Wide-field fundus photograph from neonatal ROP screening:
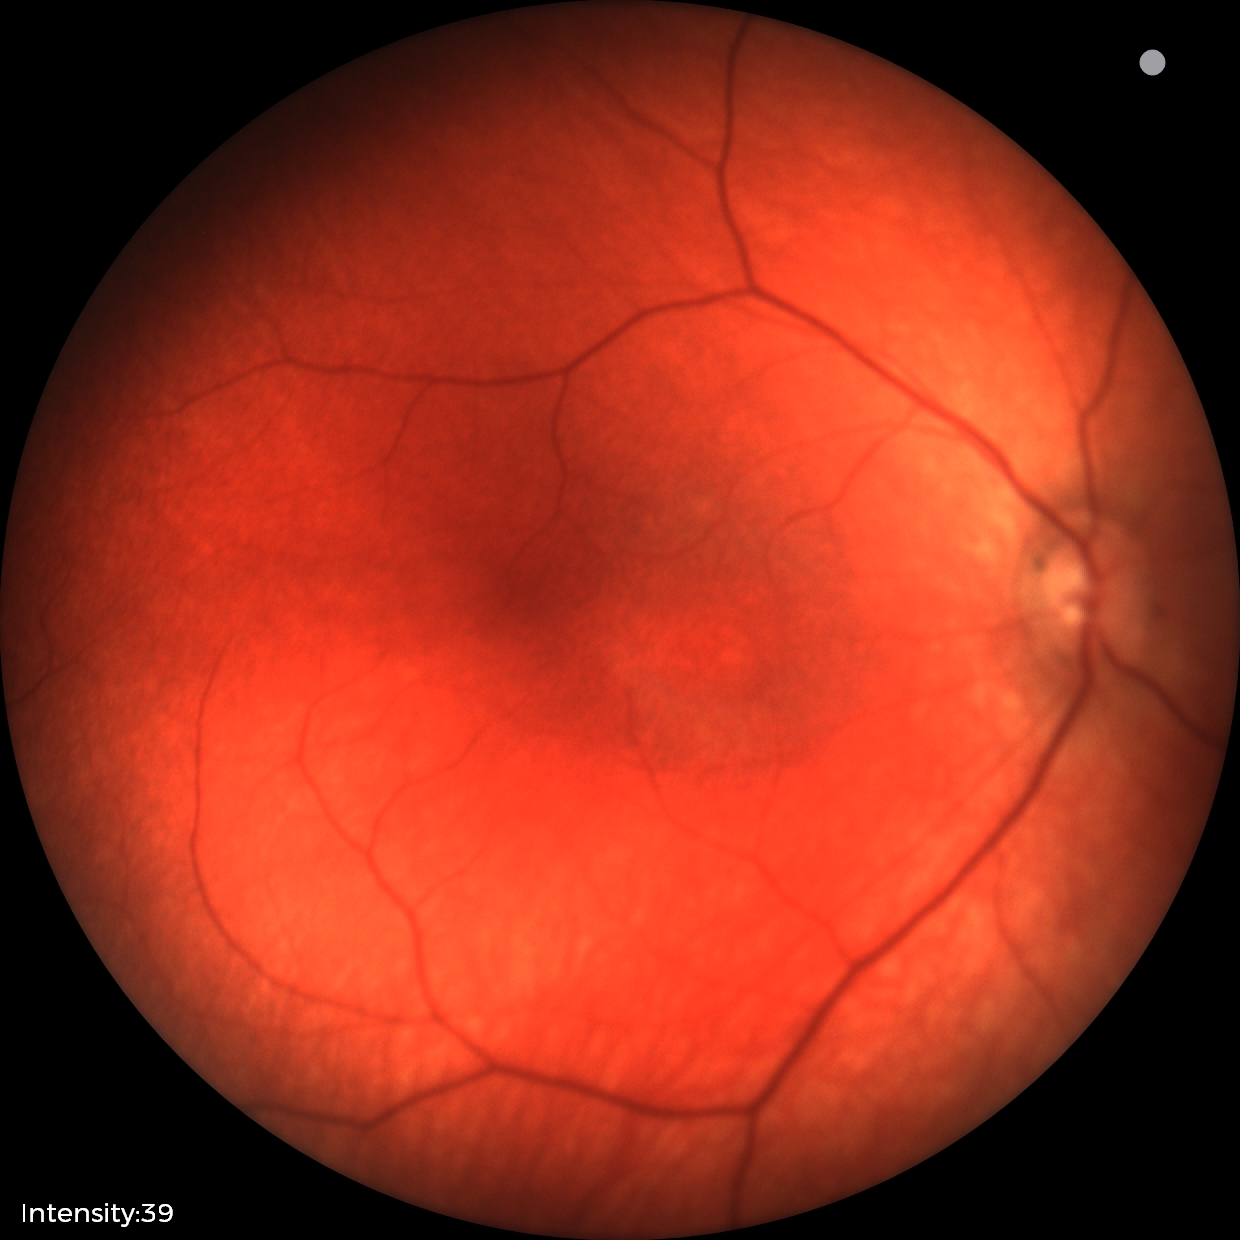
Screening examination with no abnormal retinal findings.